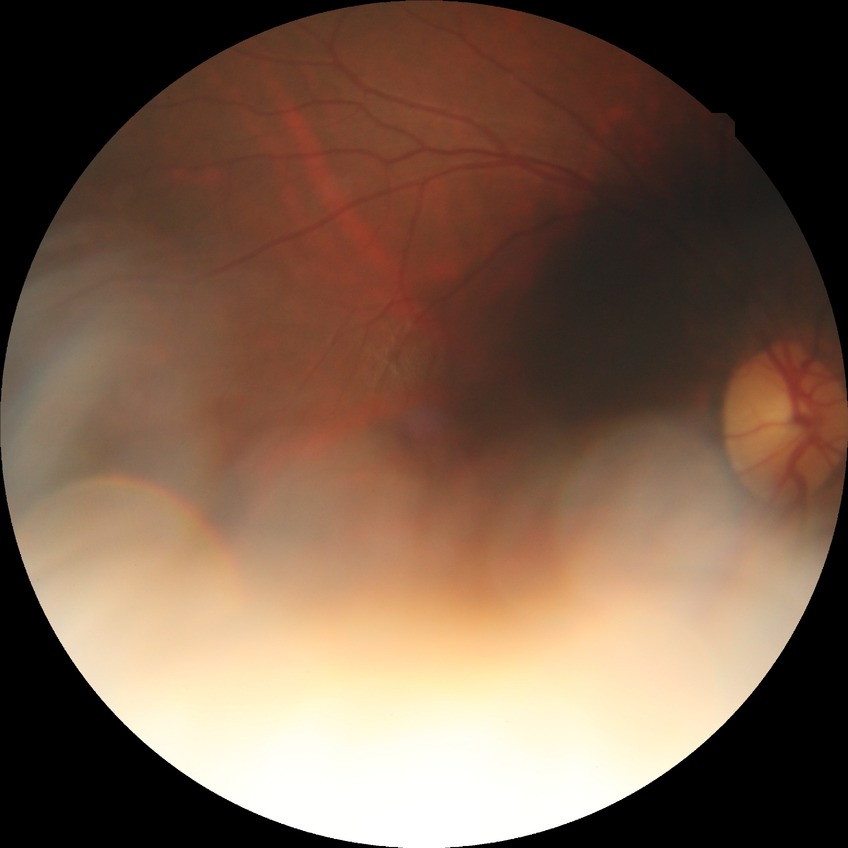

Modified Davis grading is no diabetic retinopathy.